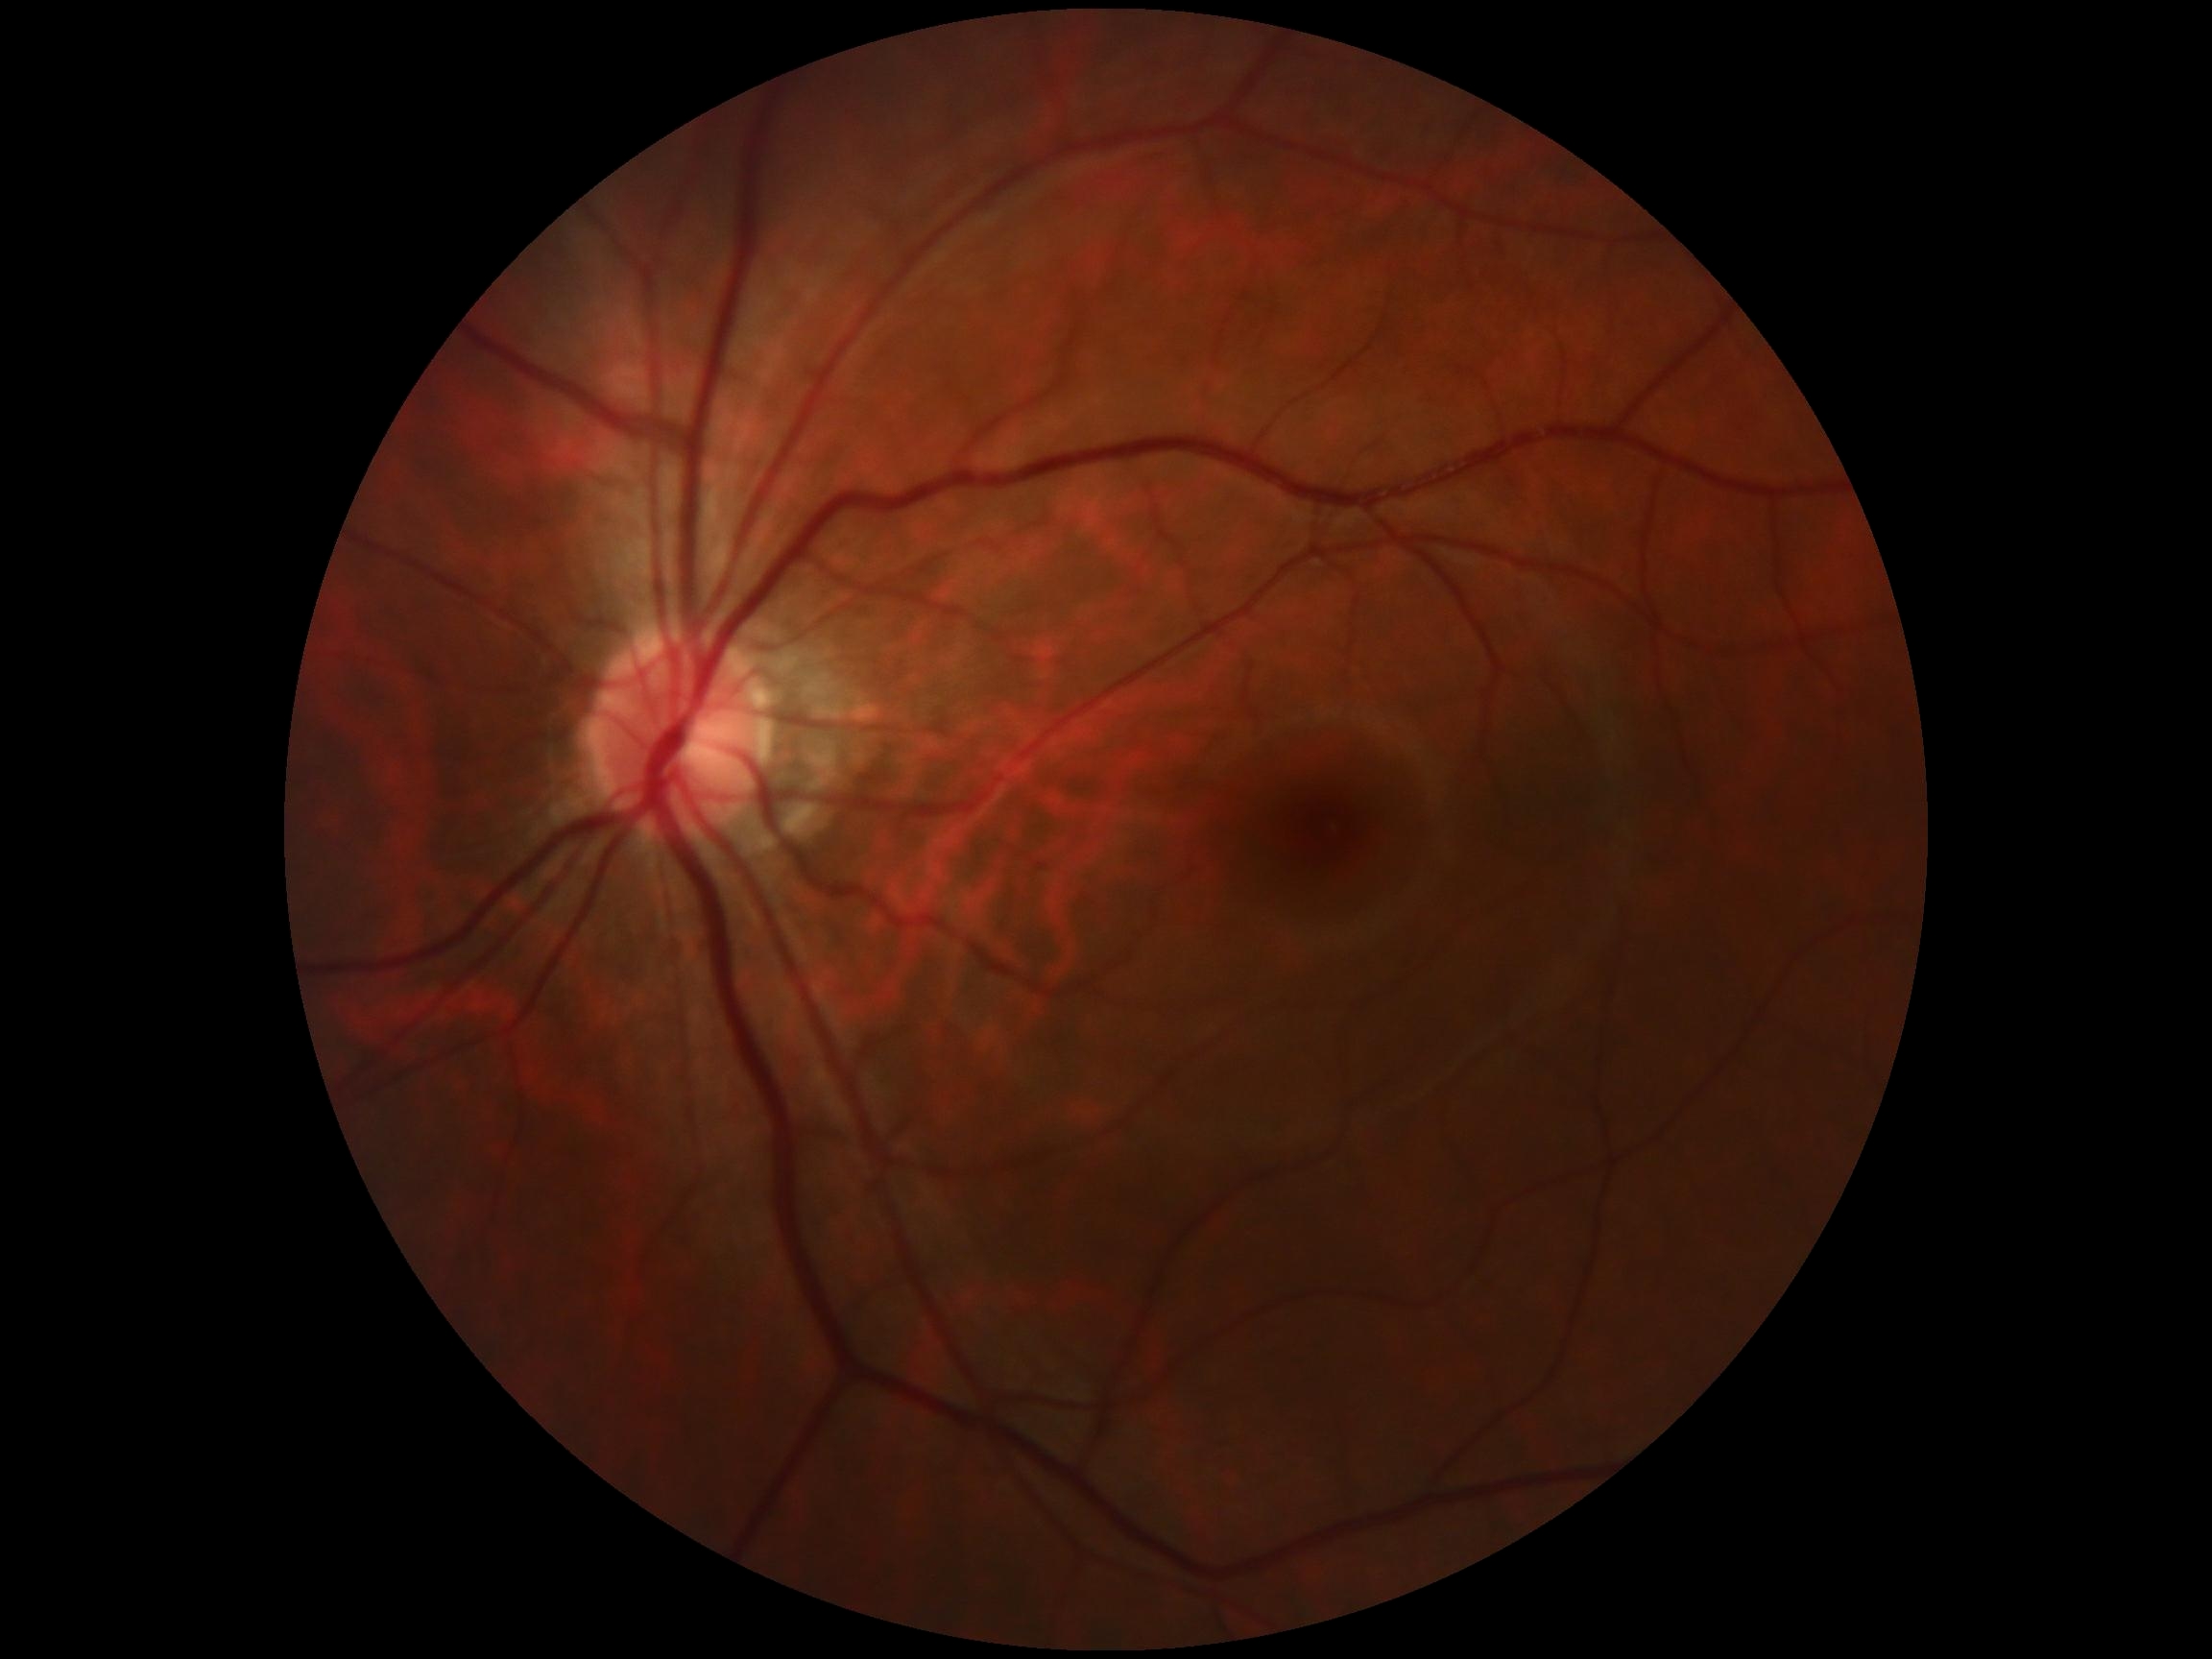 retinopathy grade: 0.